Diabetic retinopathy graded by the modified Davis classification: 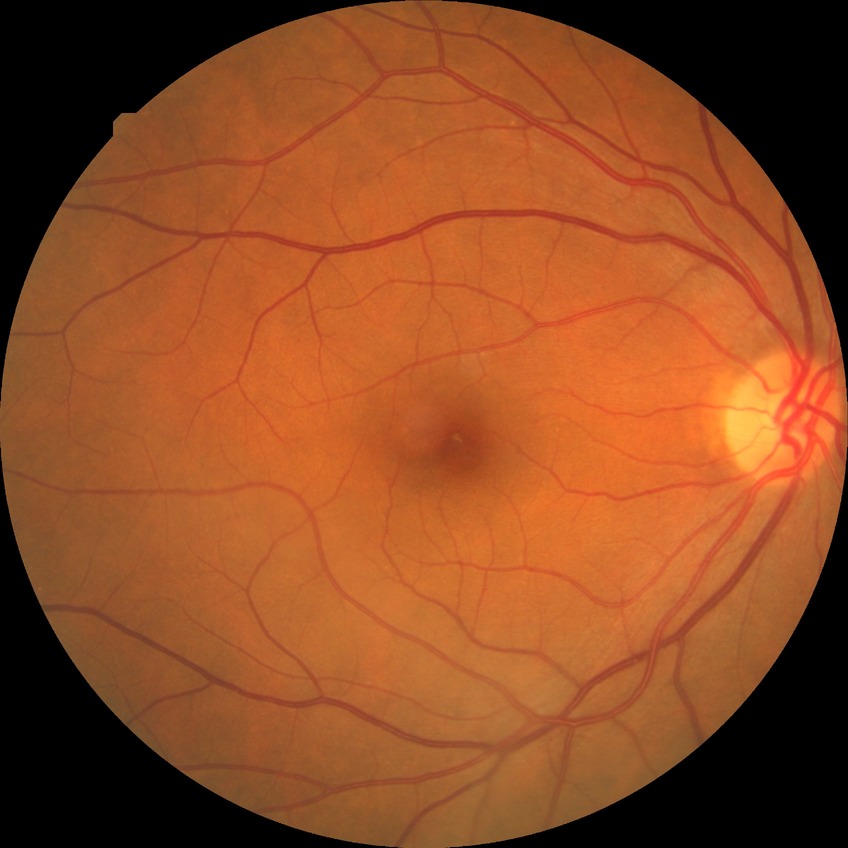 Diabetic retinopathy (DR) is NDR (no diabetic retinopathy).